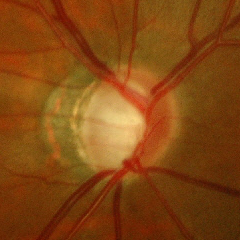 Q: Glaucoma assessment?
A: Yes — early glaucomatous changes.